FOV: 45 degrees — 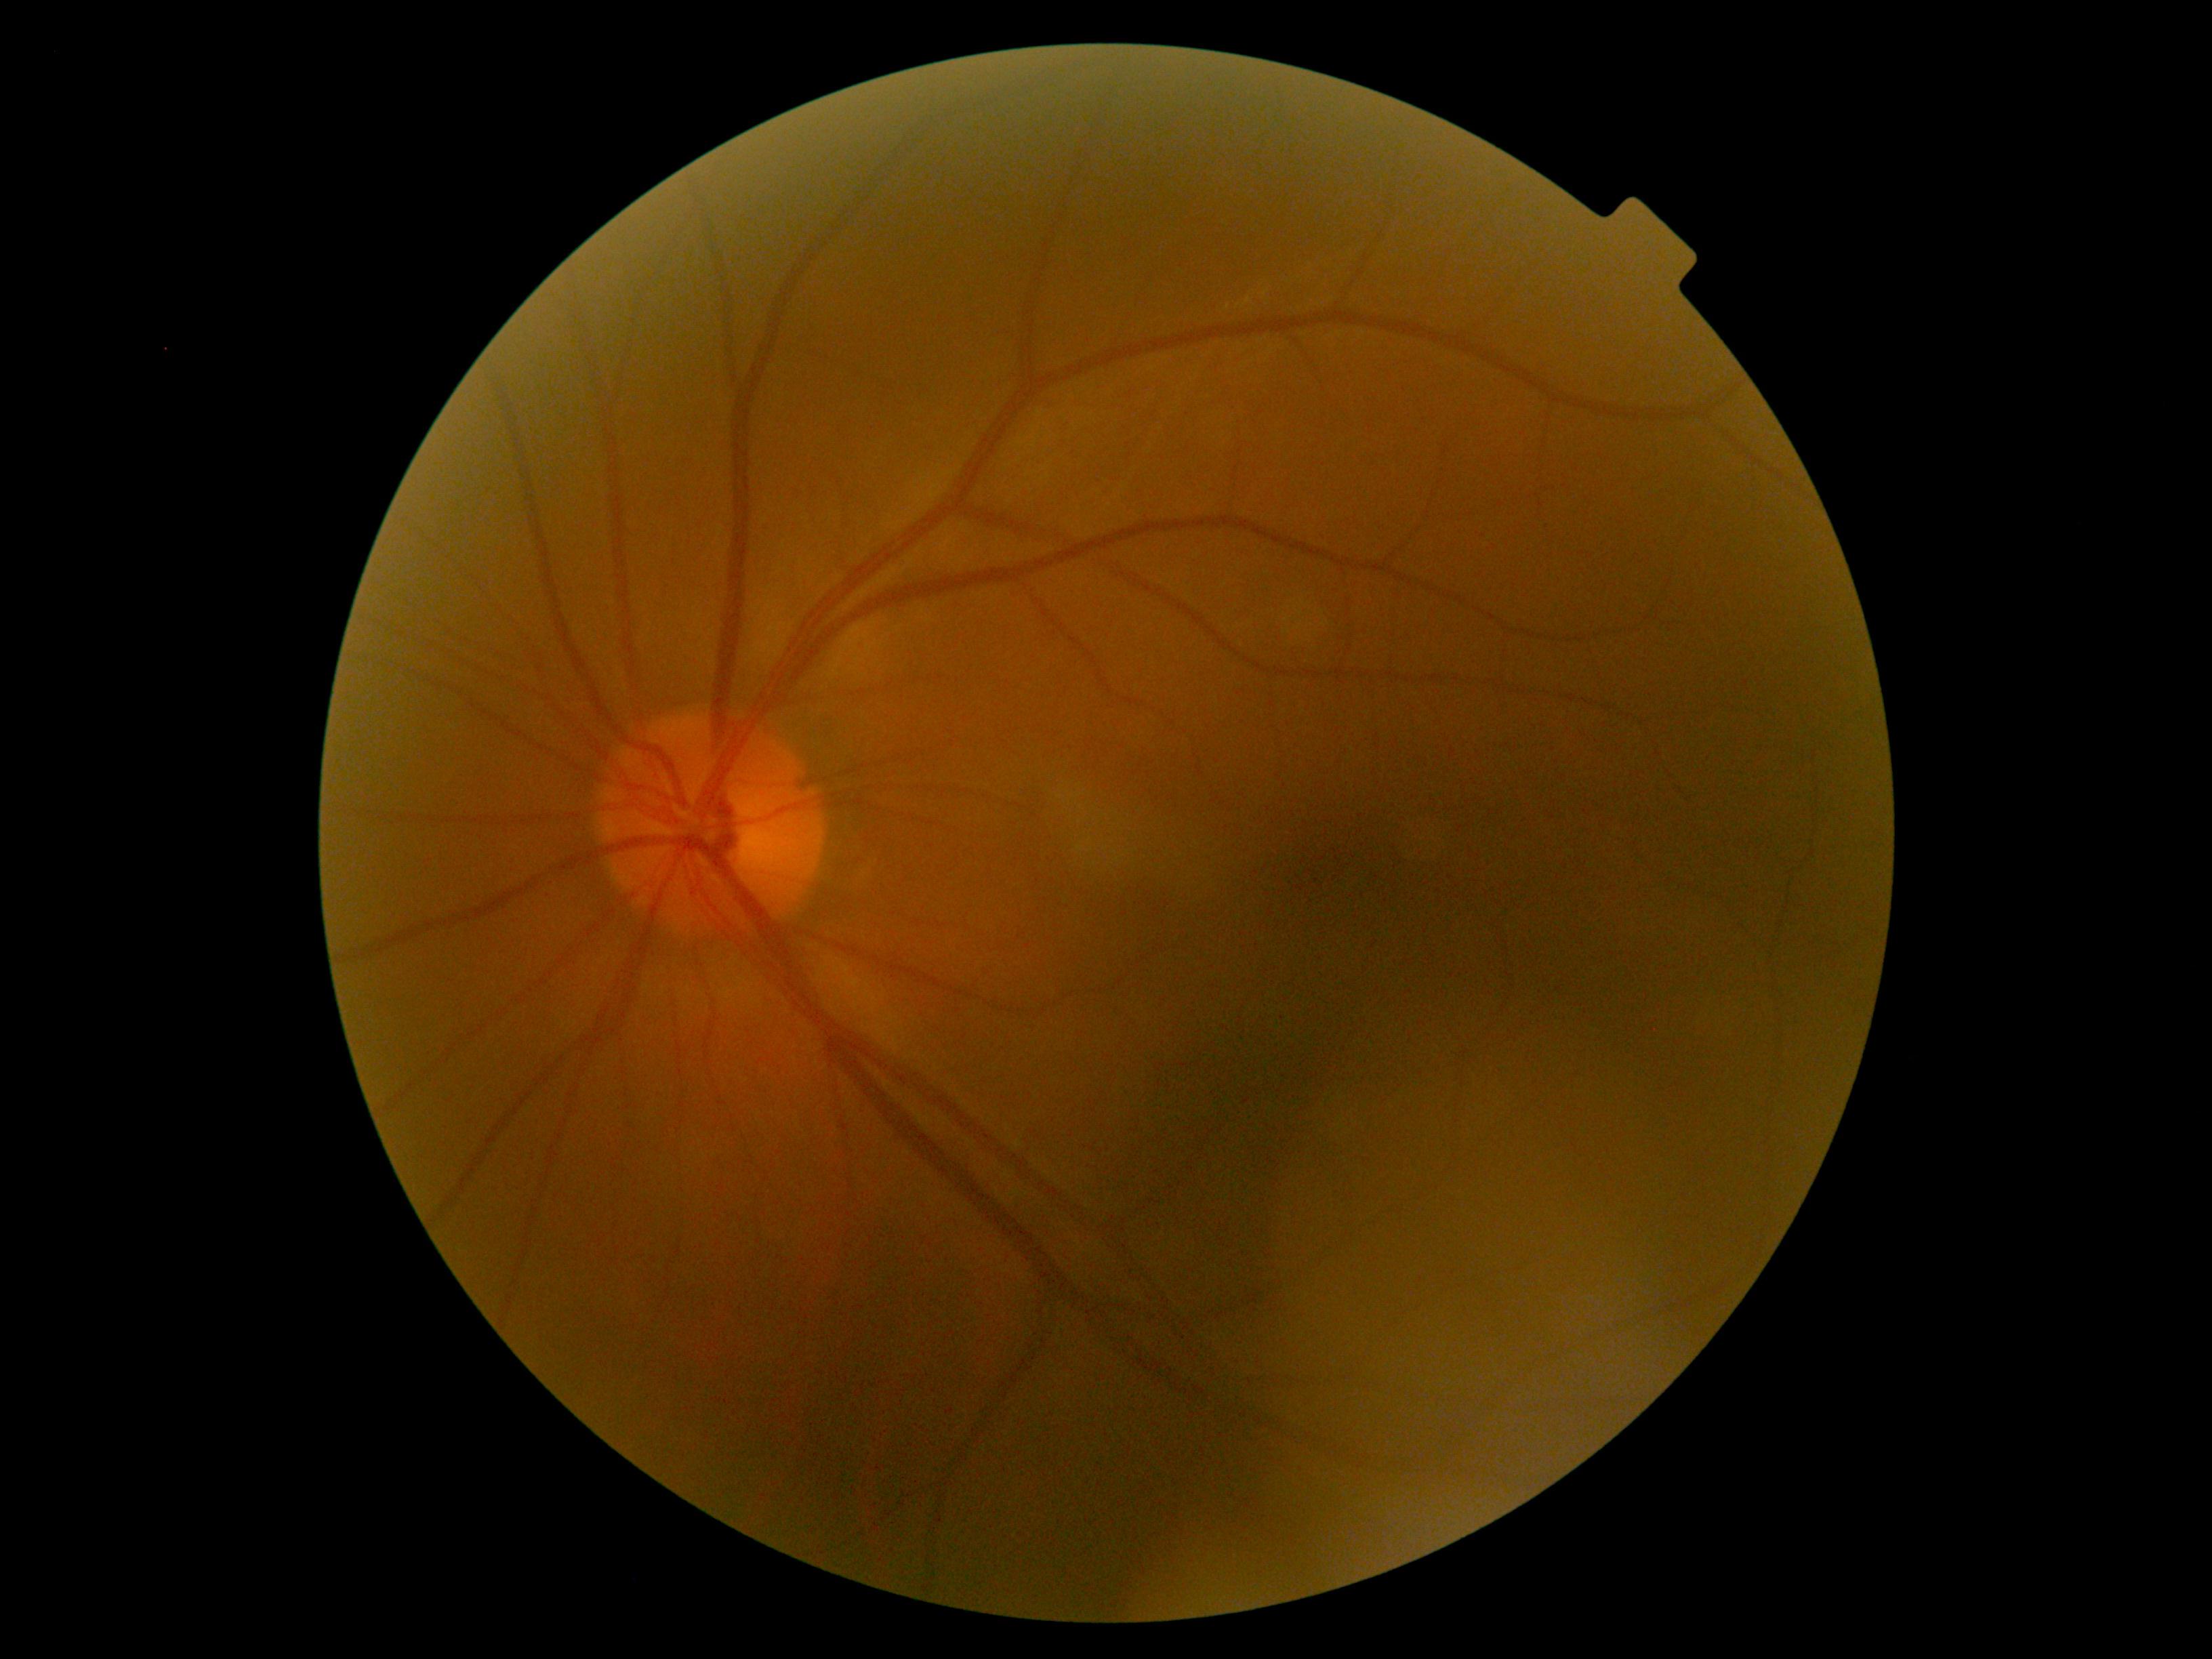

No apparent diabetic retinopathy.
Retinopathy grade is 0.